NIDEK AFC-230: 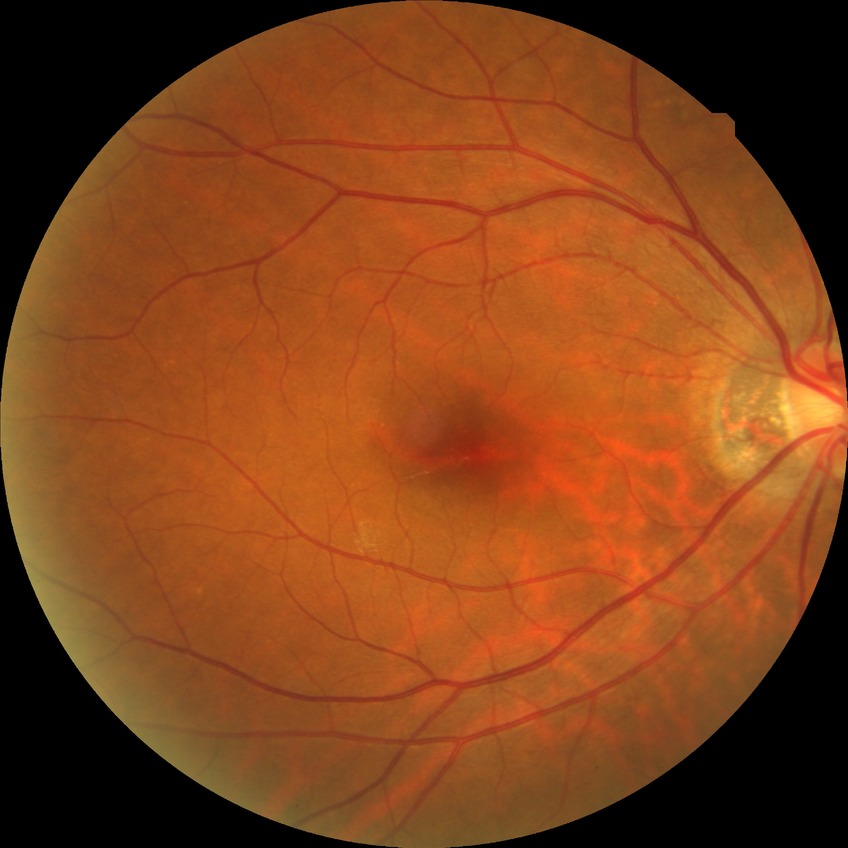

diabetic retinopathy (DR): no diabetic retinopathy (NDR).